1659 by 2212 pixels · acquired with a Remidio Fundus on Phone (FOP) camera · color fundus image — 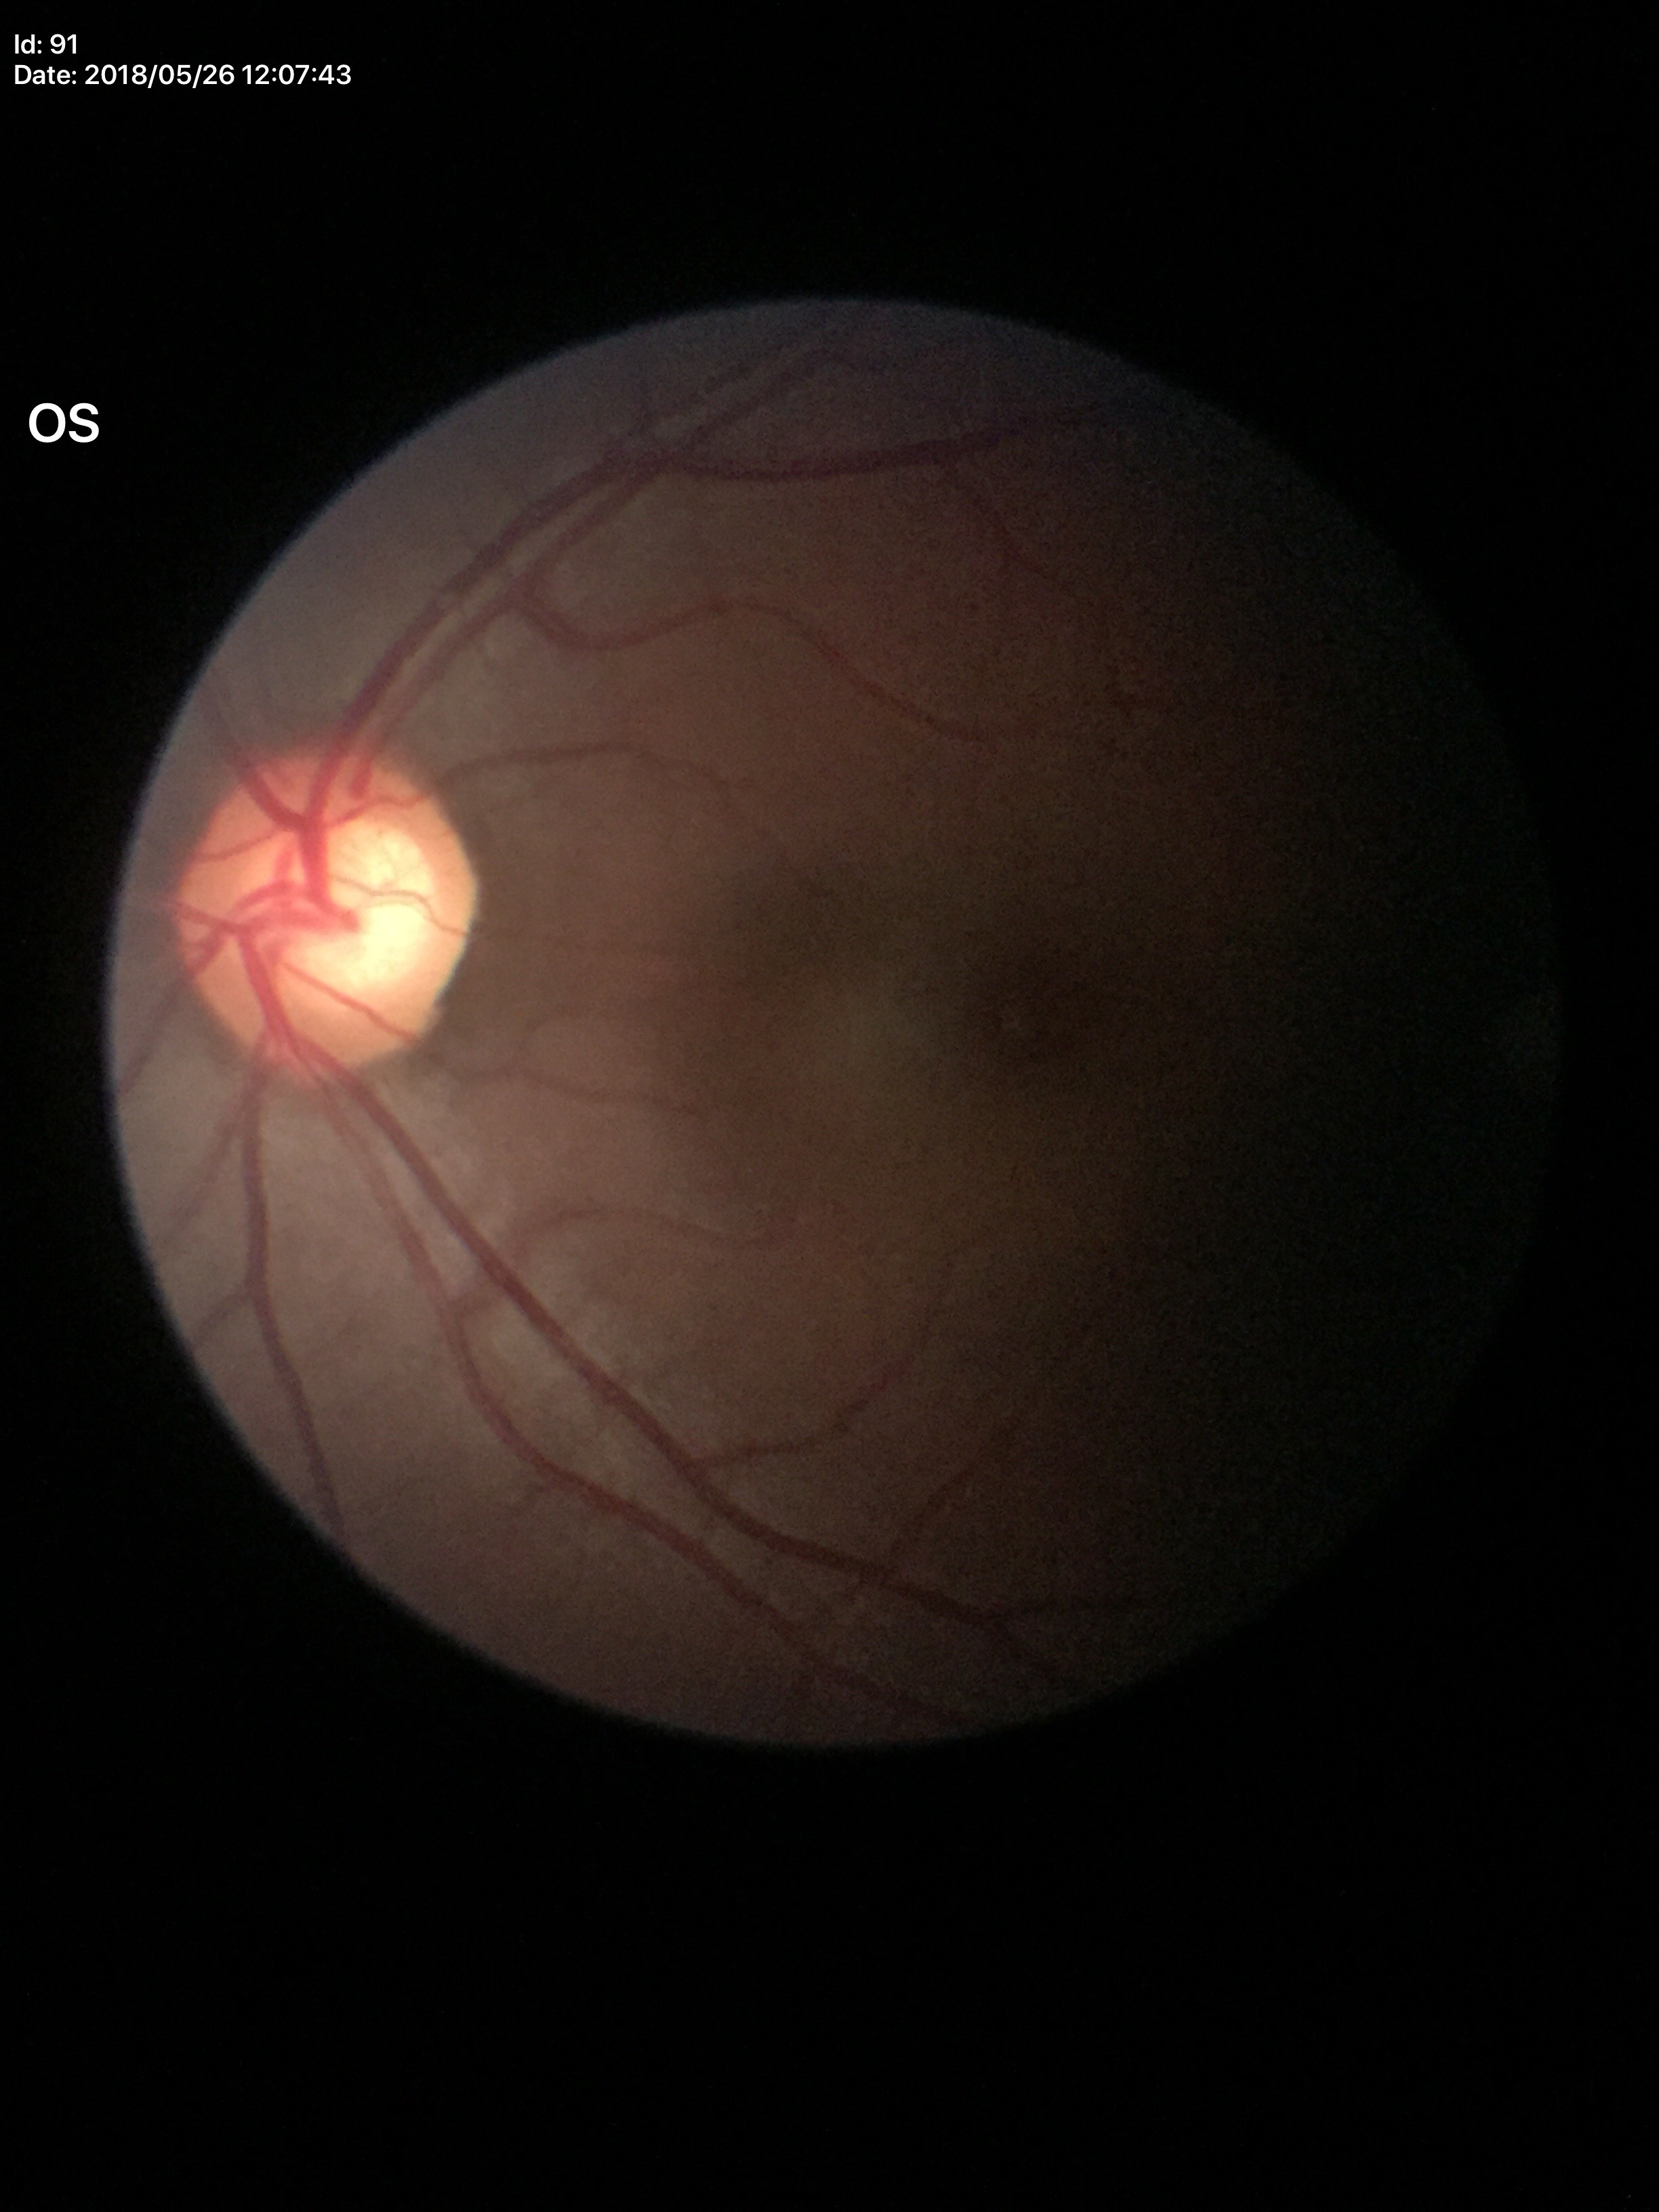

Optic disc analysis:
- Glaucoma impression — suspicious findings (3 of 5 graders flagged glaucoma suspect)
- vertical CDR — 0.62